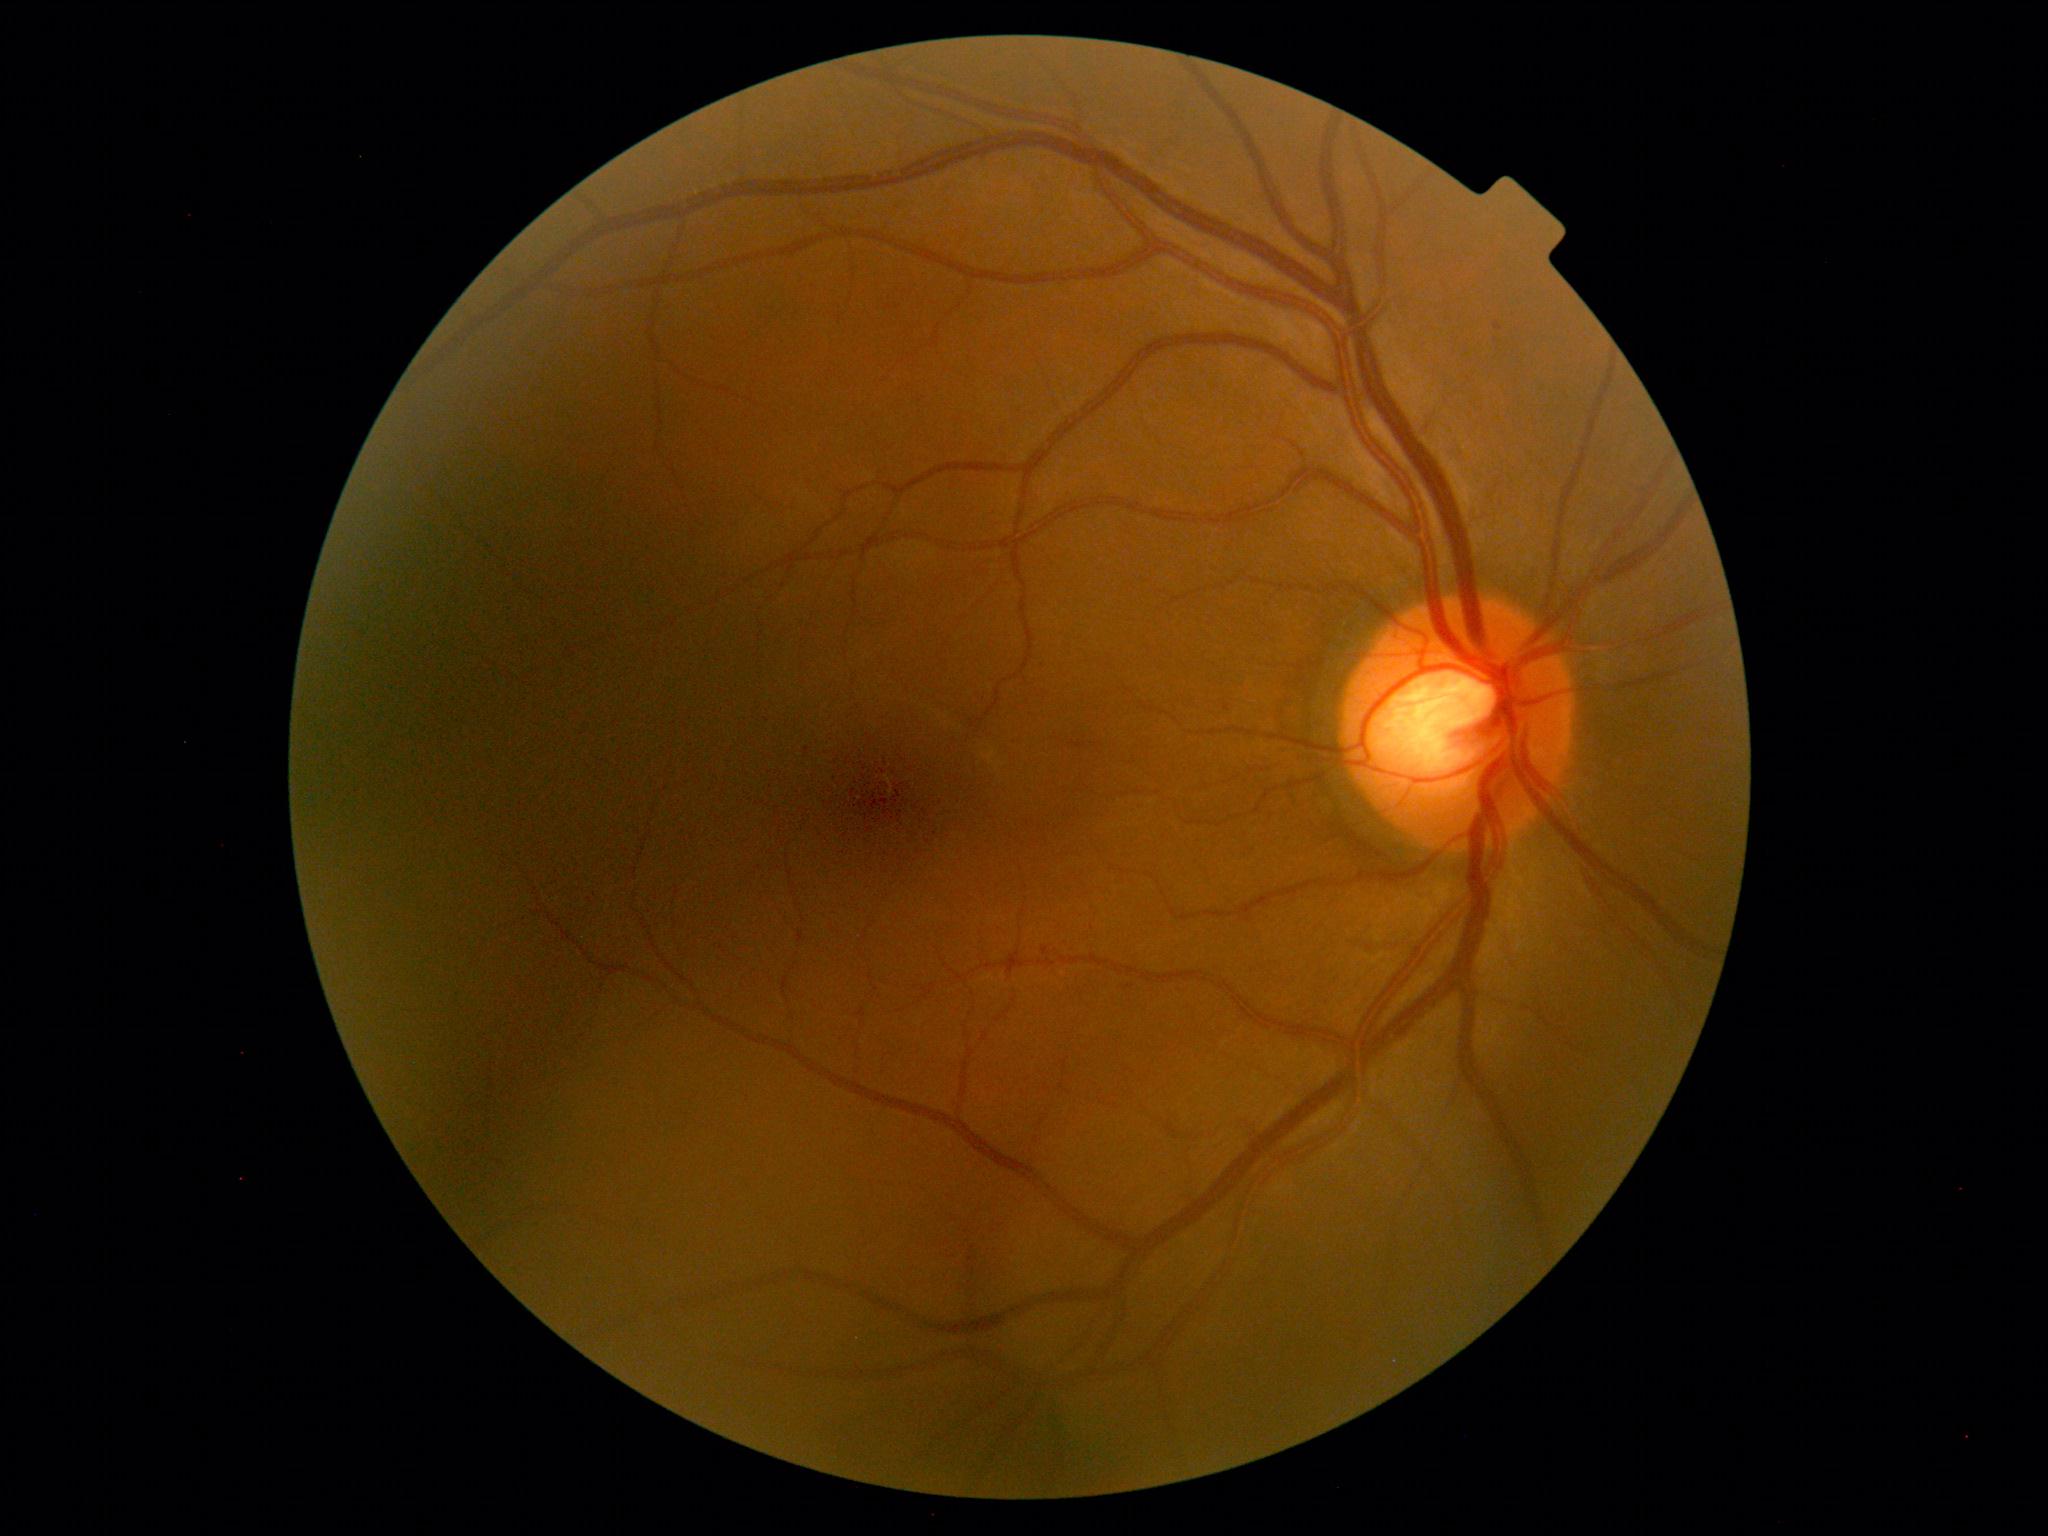 Disease class: non-proliferative diabetic retinopathy. DR stage is grade 1.